Retinal fundus photograph, camera: Remidio smartphone fundus camera
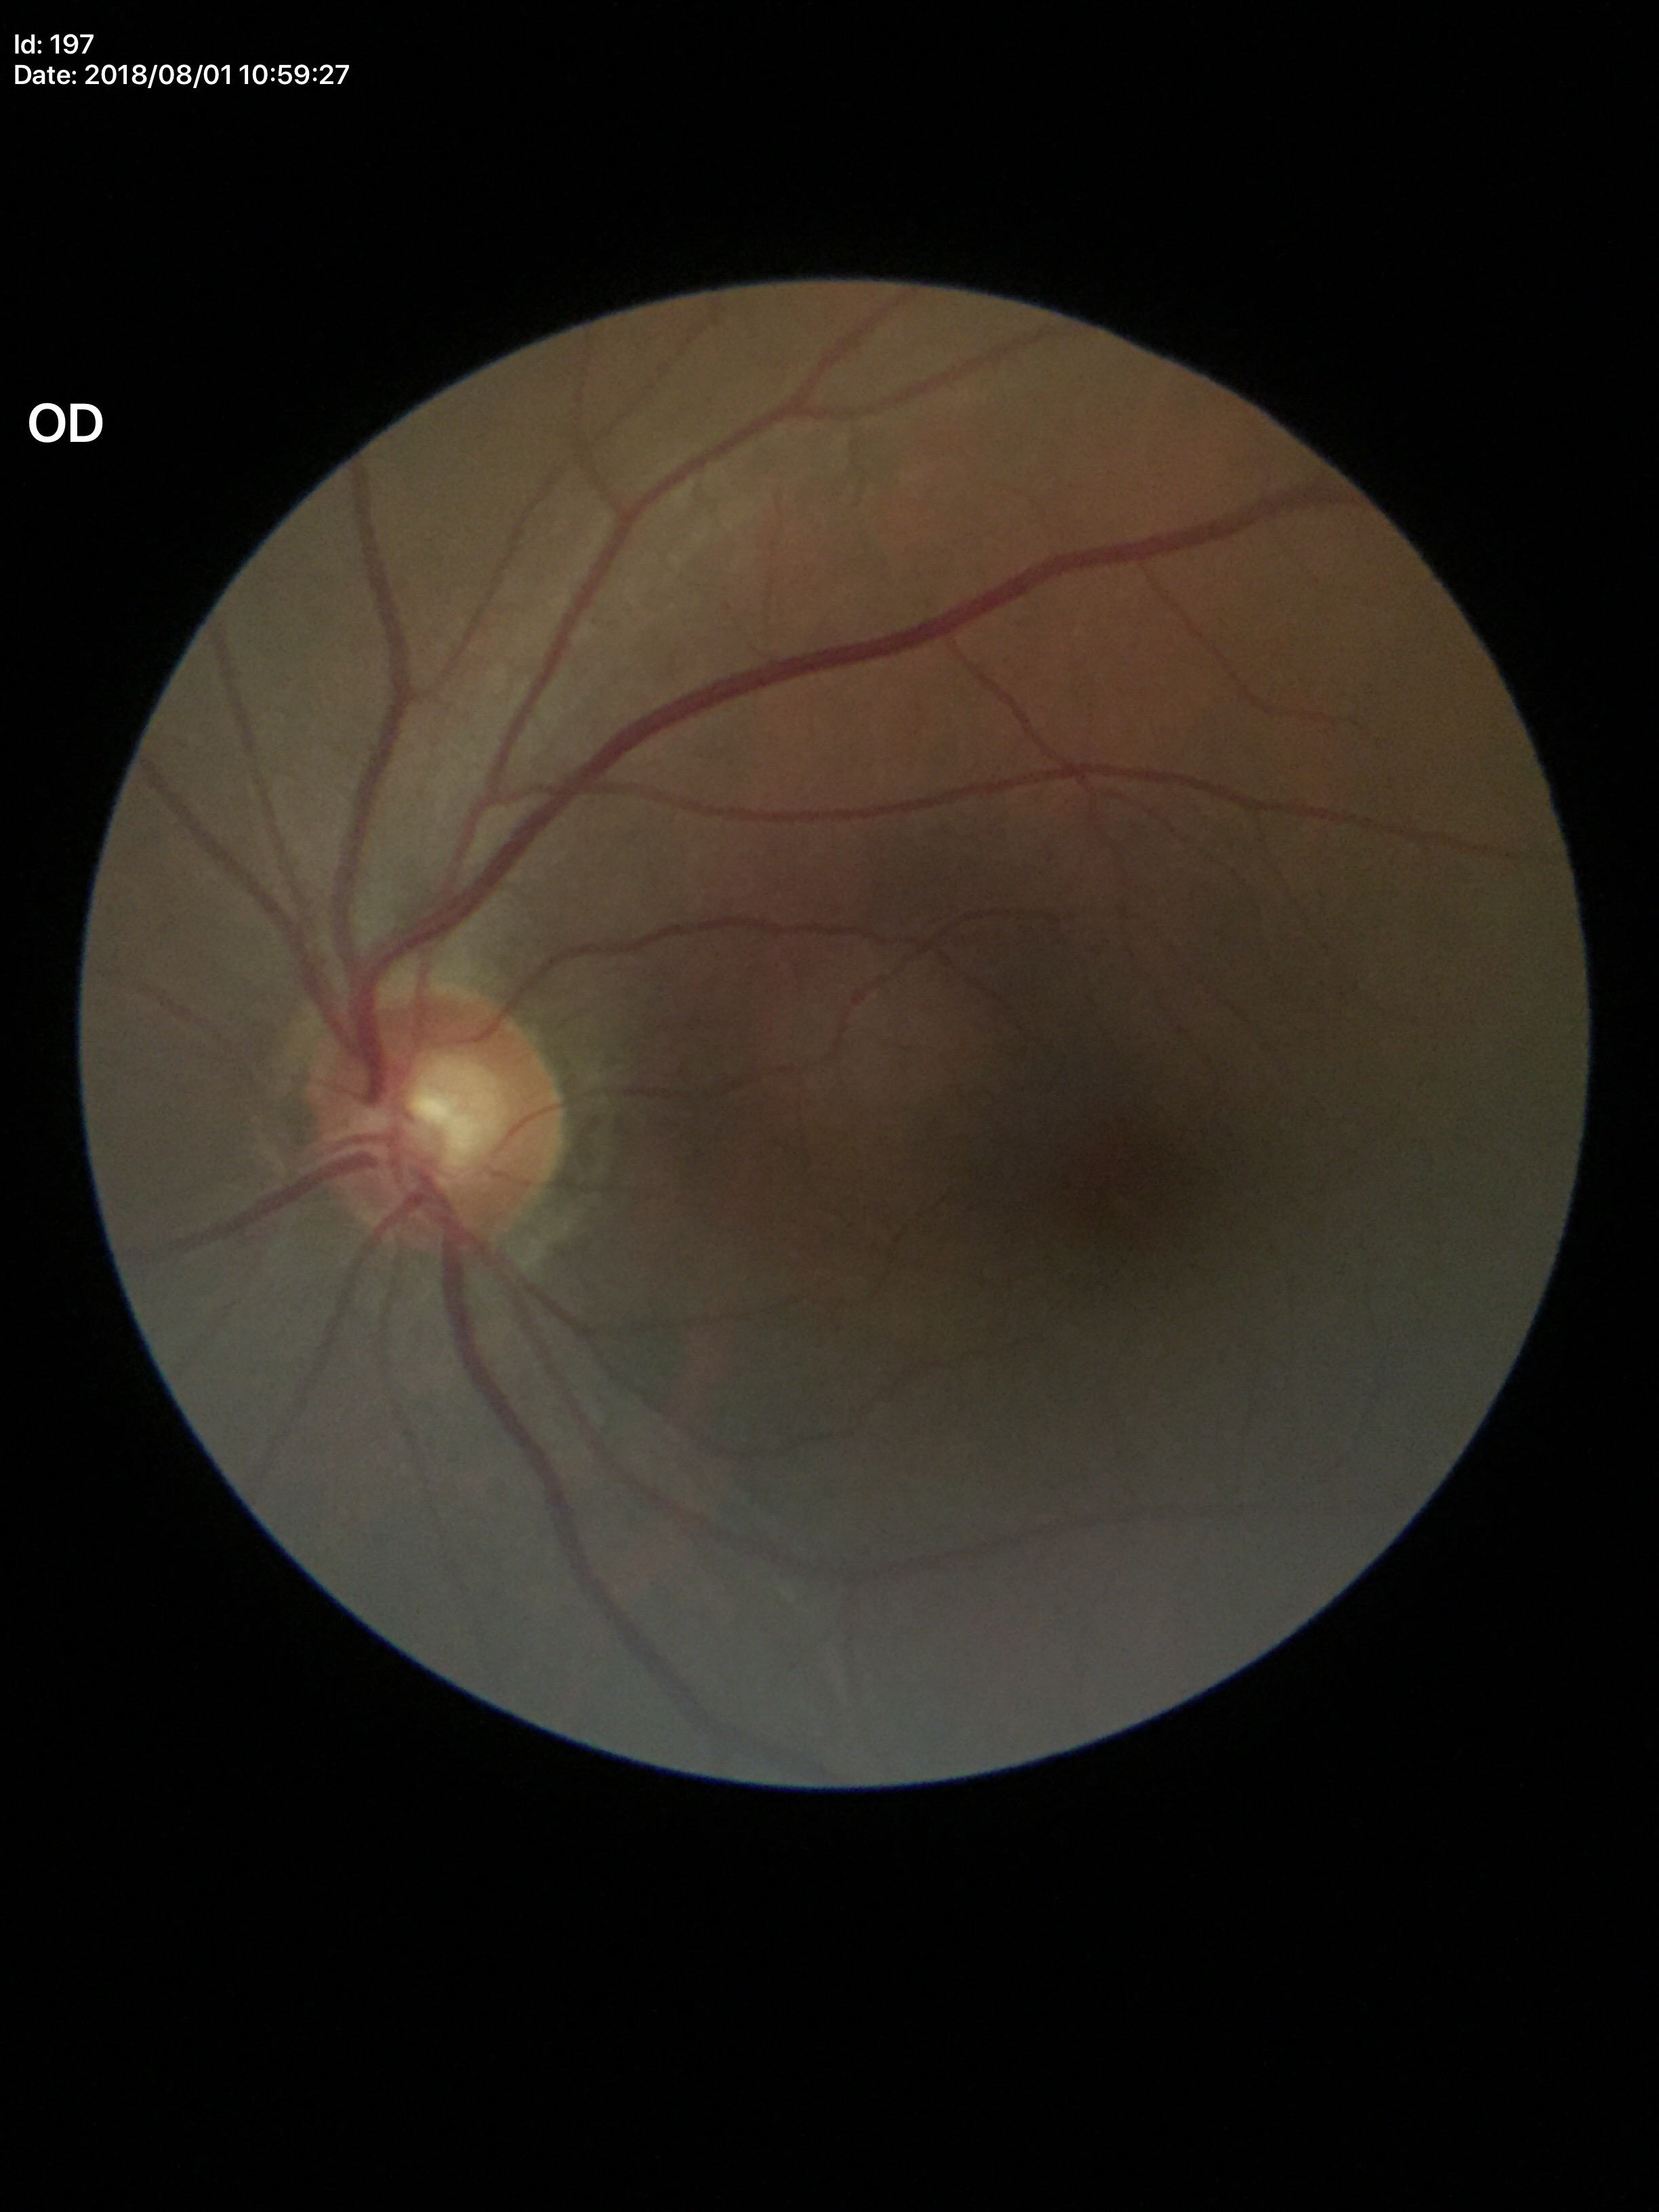
Horizontal C/D ratio of 0.59. Vertical cup-disc ratio is 0.58. No evidence of glaucoma.